Wide-field retinal mosaic image
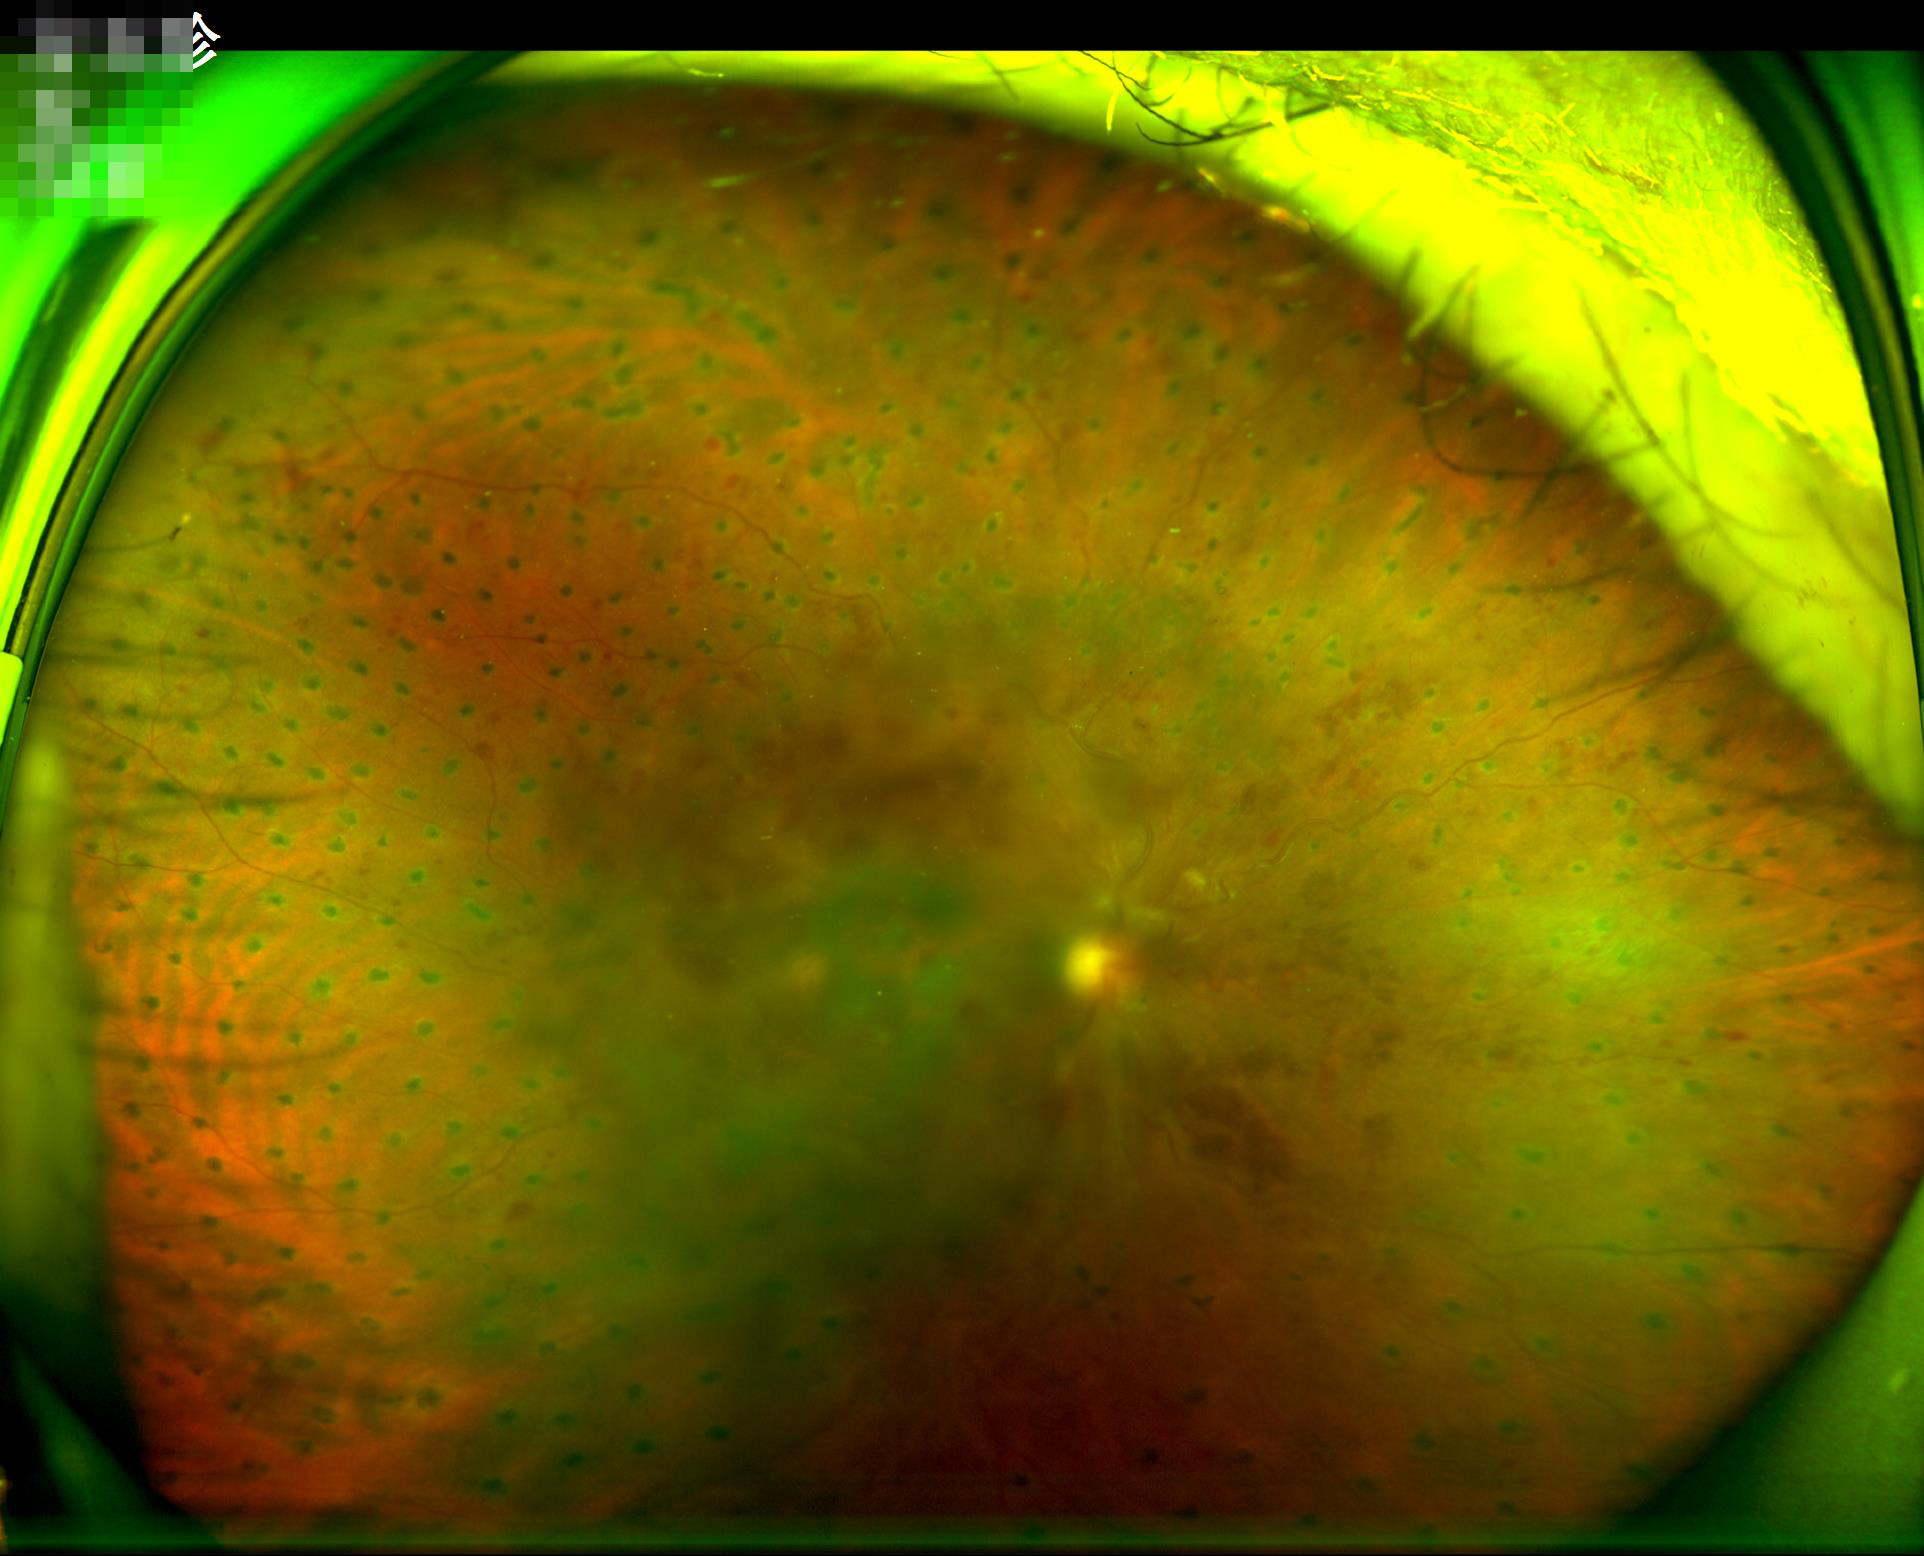

The image is blurry.
Overall quality is poor; the image is difficult to grade.
Illumination and color balance are good.
Narrow intensity range; structures are hard to distinguish.